45° FOV; 2048x1536px
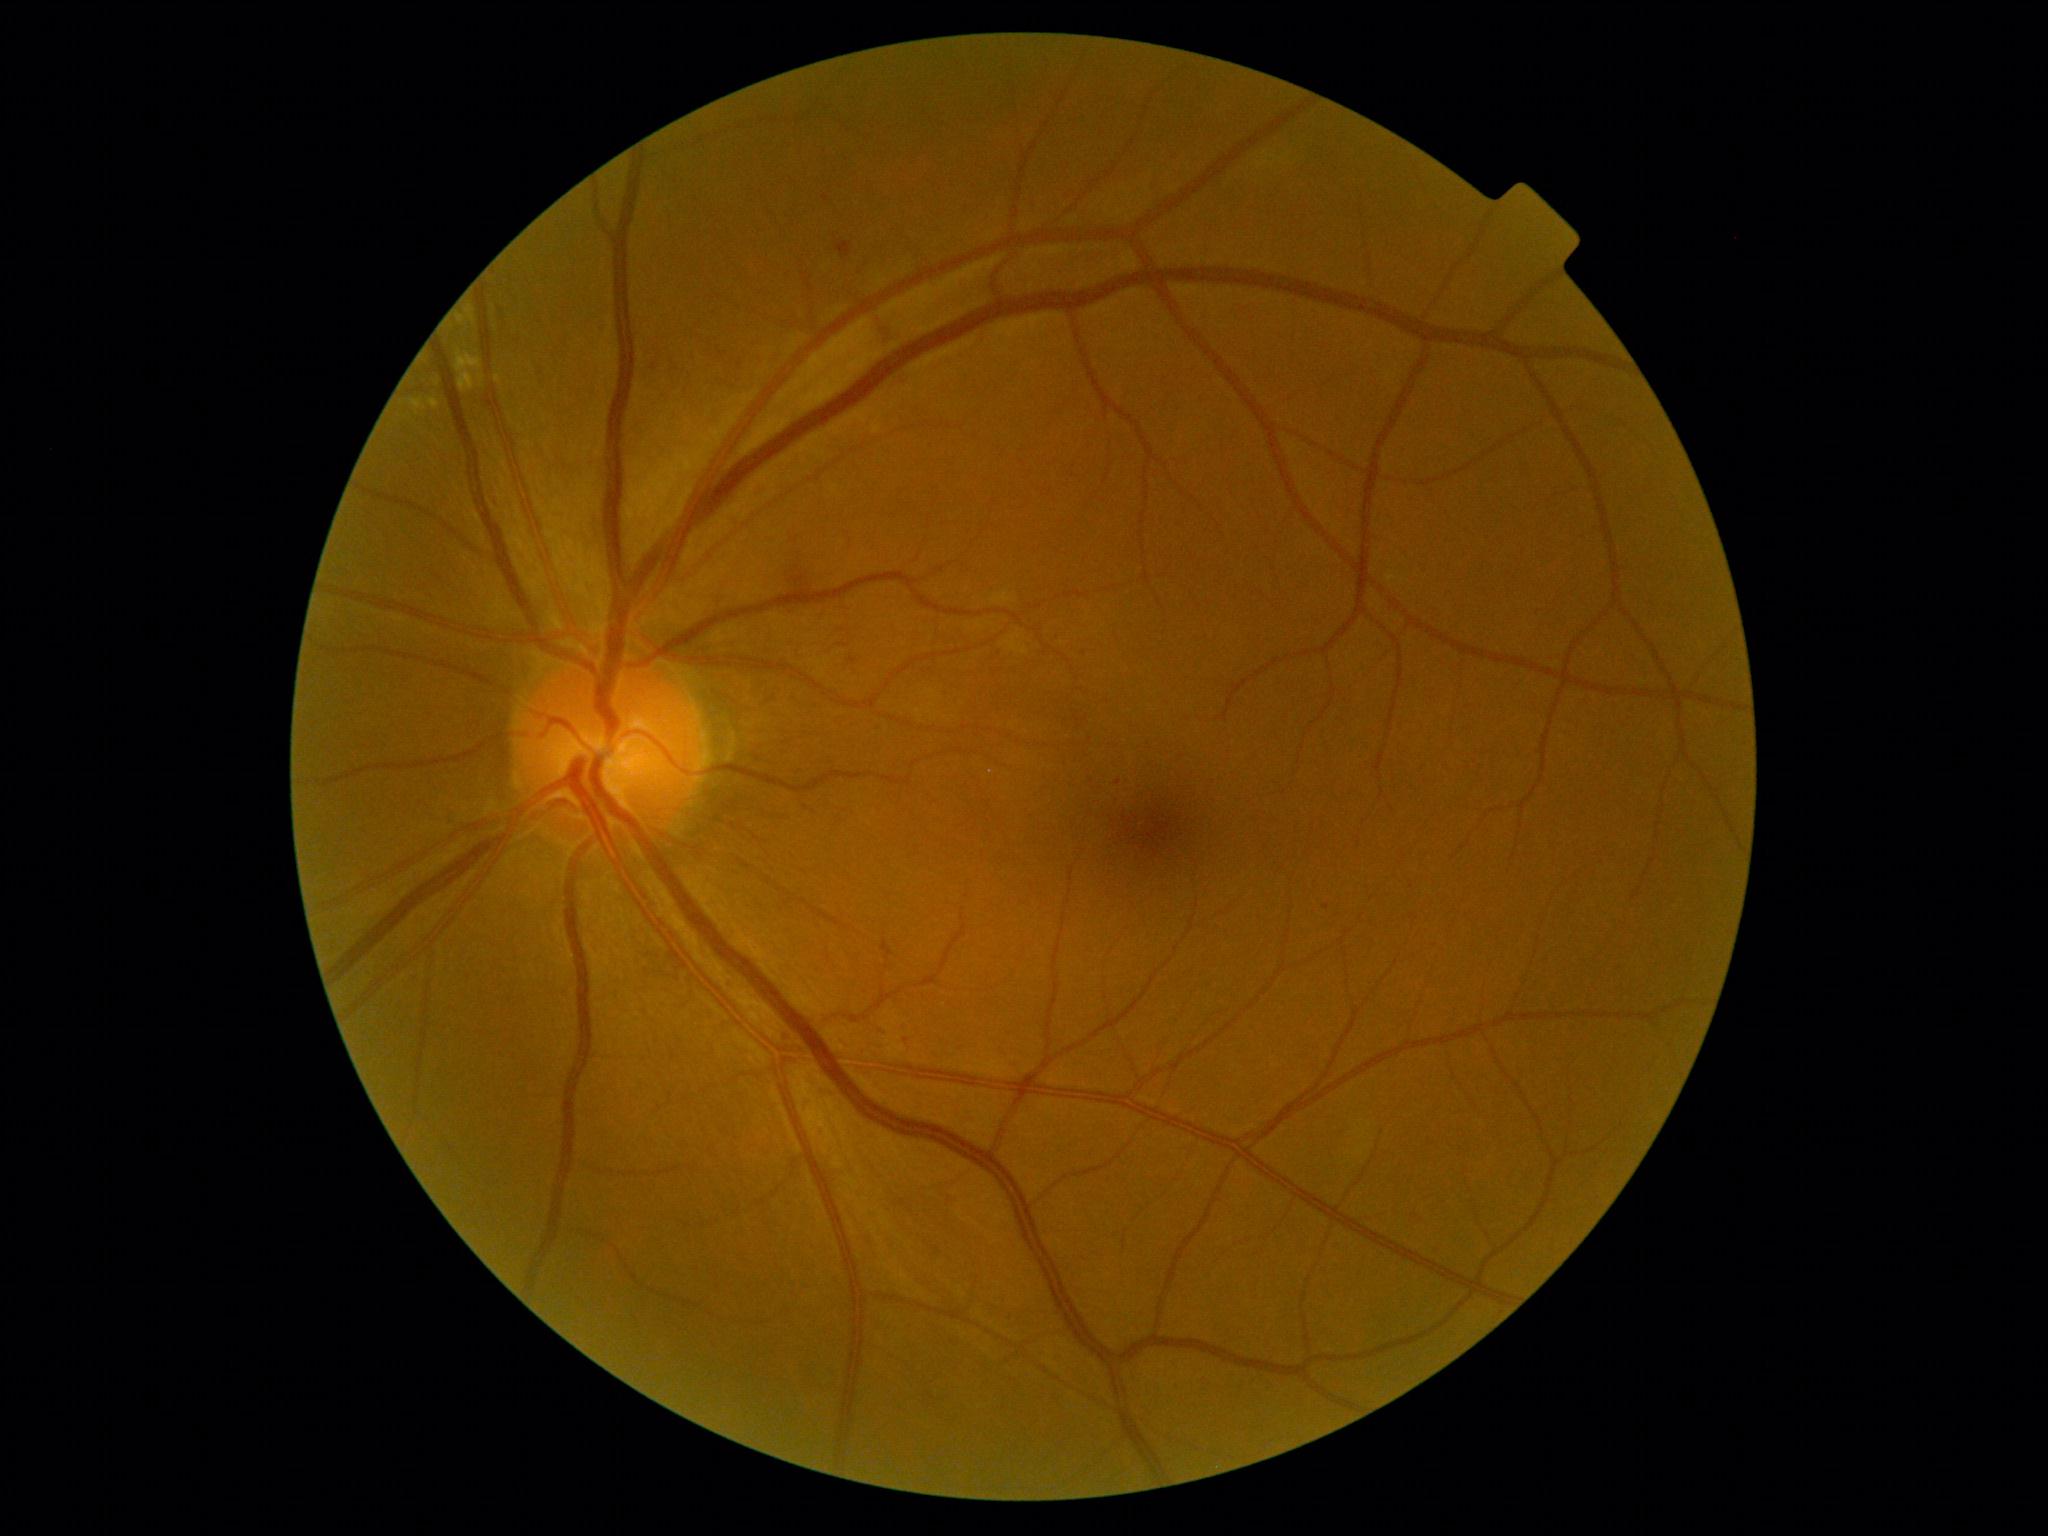 DR class = non-proliferative diabetic retinopathy; DR grade = 2.